2352x1568 · 45° FOV · color fundus image — 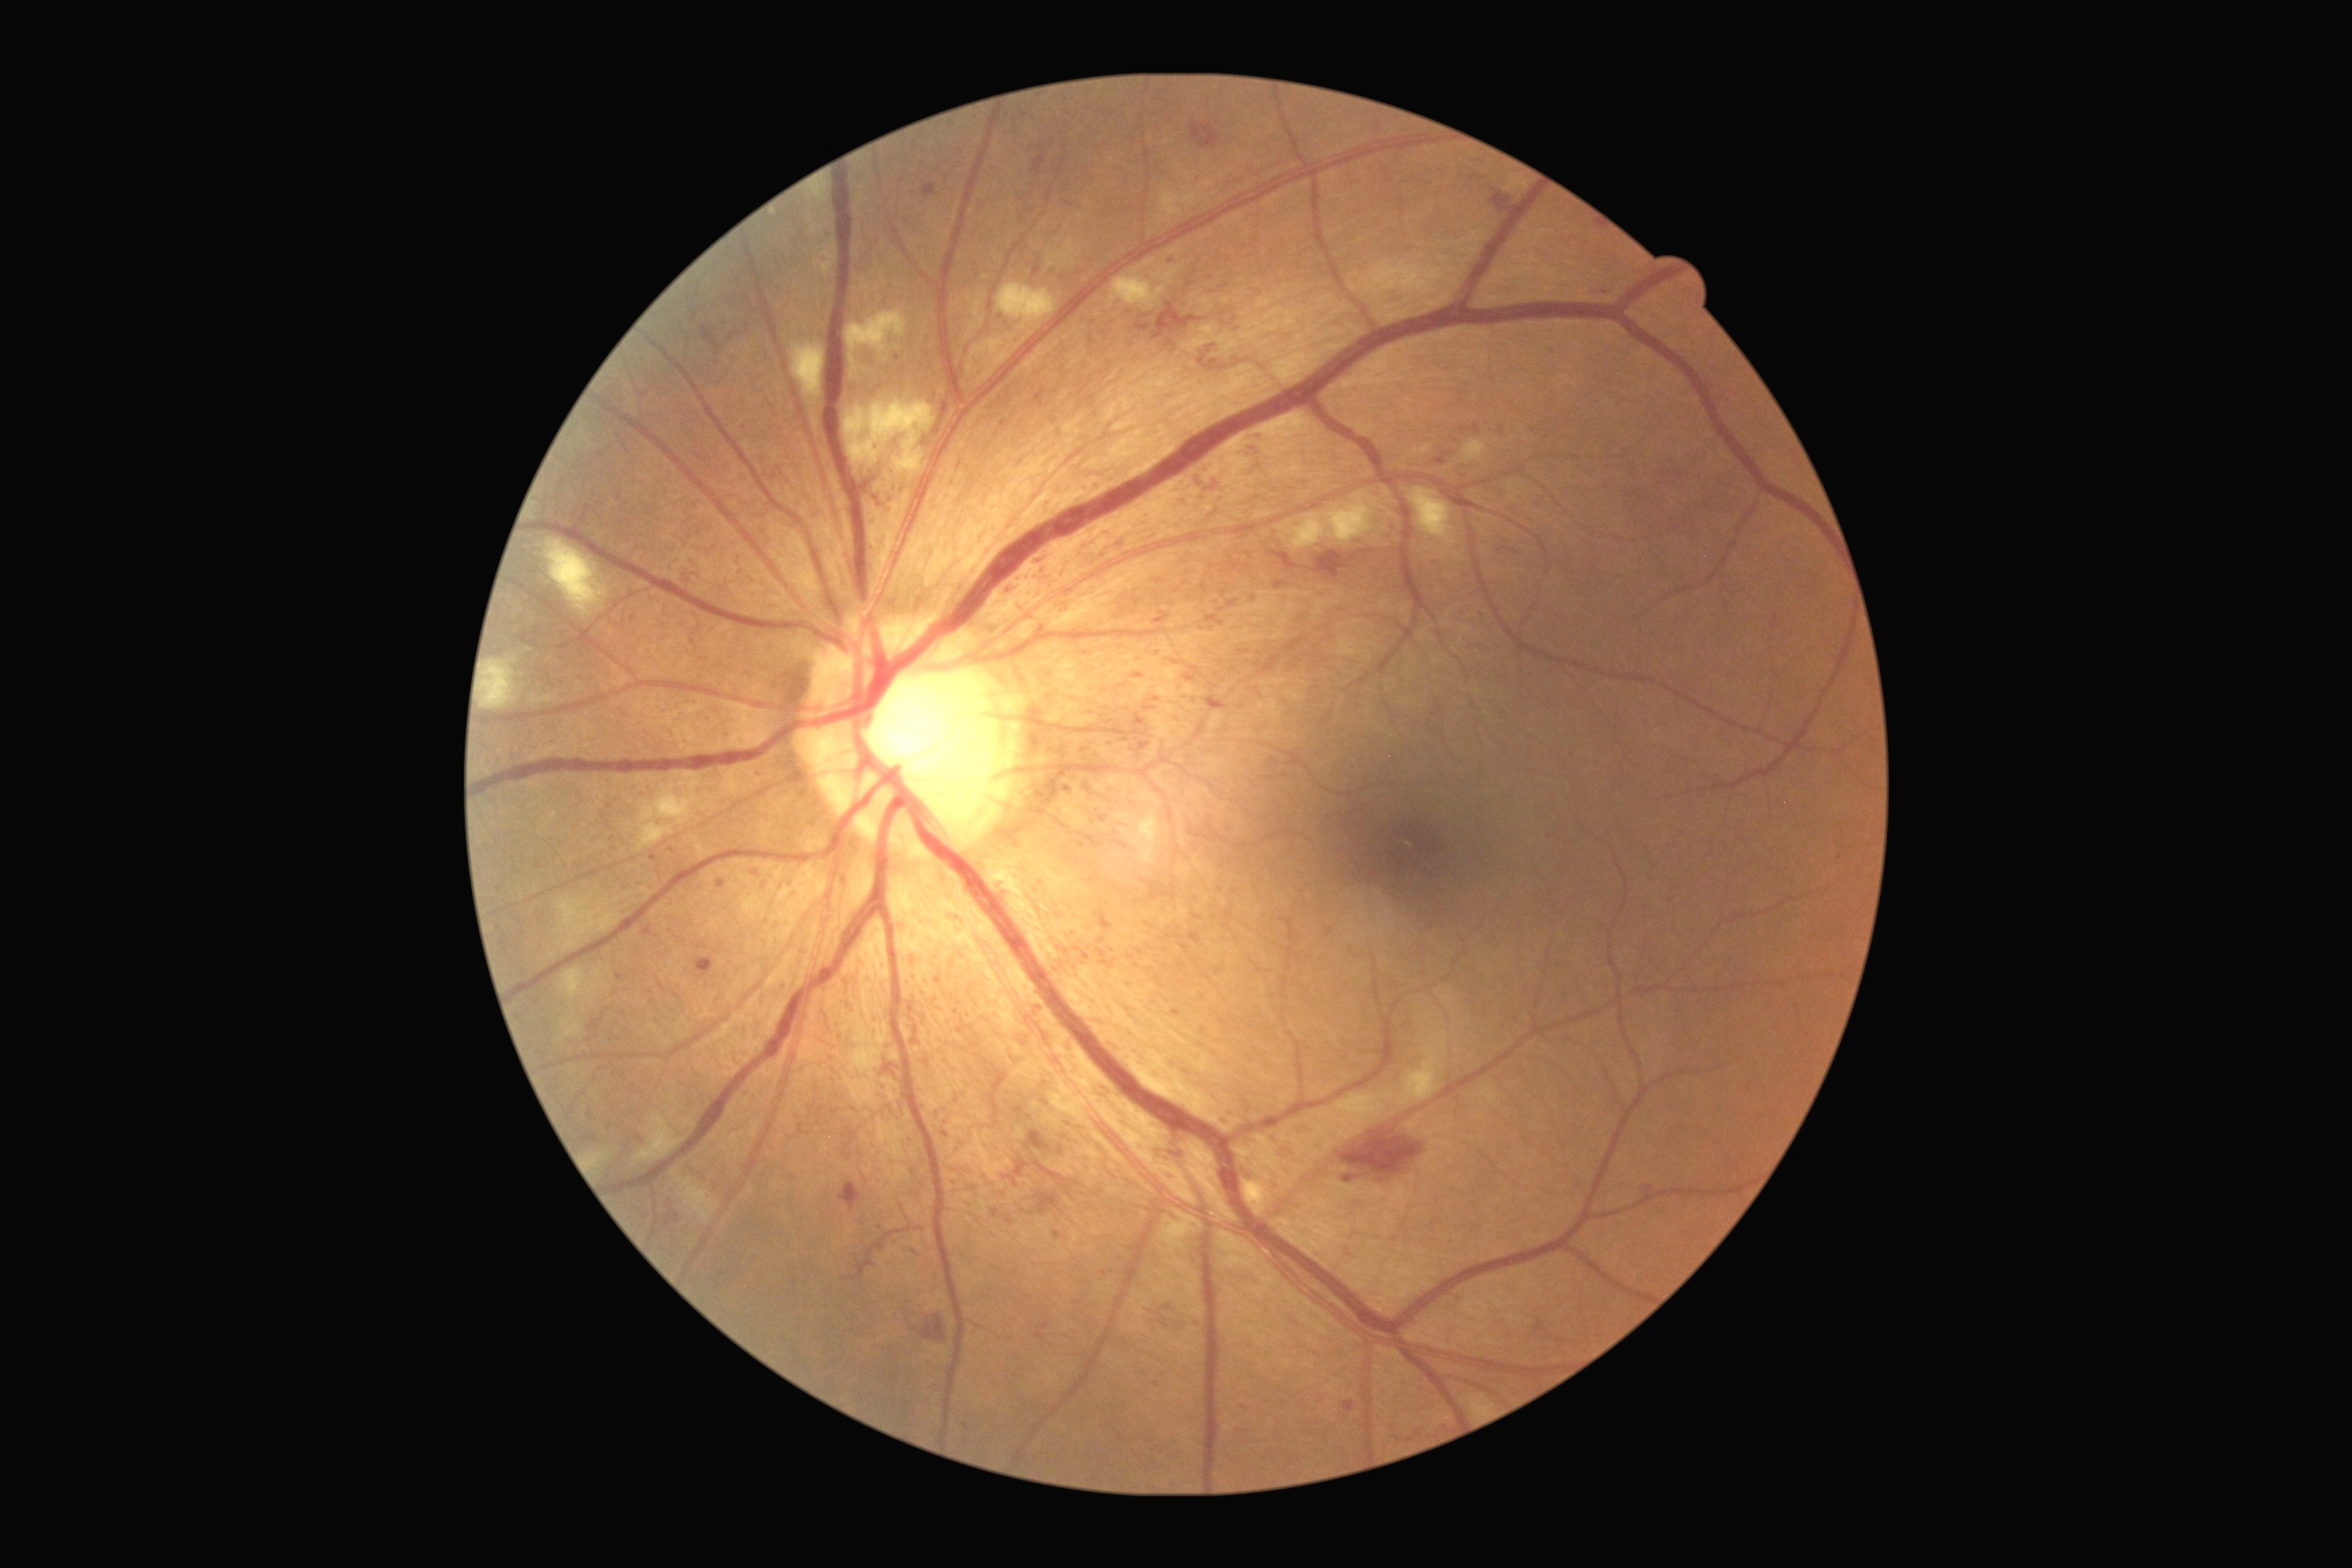
partial: true
dr_grade: 3
lesions:
  ma:
    - <bbox>1034, 264, 1041, 277</bbox>
    - <bbox>1159, 1322, 1168, 1328</bbox>
    - <bbox>1168, 1171, 1175, 1182</bbox>
    - <bbox>1206, 614, 1224, 627</bbox>
    - <bbox>1219, 284, 1228, 291</bbox>
    - <bbox>1133, 714, 1146, 727</bbox>
    - <bbox>651, 856, 660, 863</bbox>
    - <bbox>1273, 582, 1286, 591</bbox>
    - <bbox>1006, 1220, 1014, 1226</bbox>
  ma_small_centers:
    - [1137, 966]
    - [1203, 1031]
    - [1089, 491]
    - [1155, 699]
    - [1187, 504]
    - [757, 873]
    - [623, 1013]
    - [1534, 431]
    - [673, 851]